Color fundus photograph; camera: Kowa VX-10α; macula-centered field — 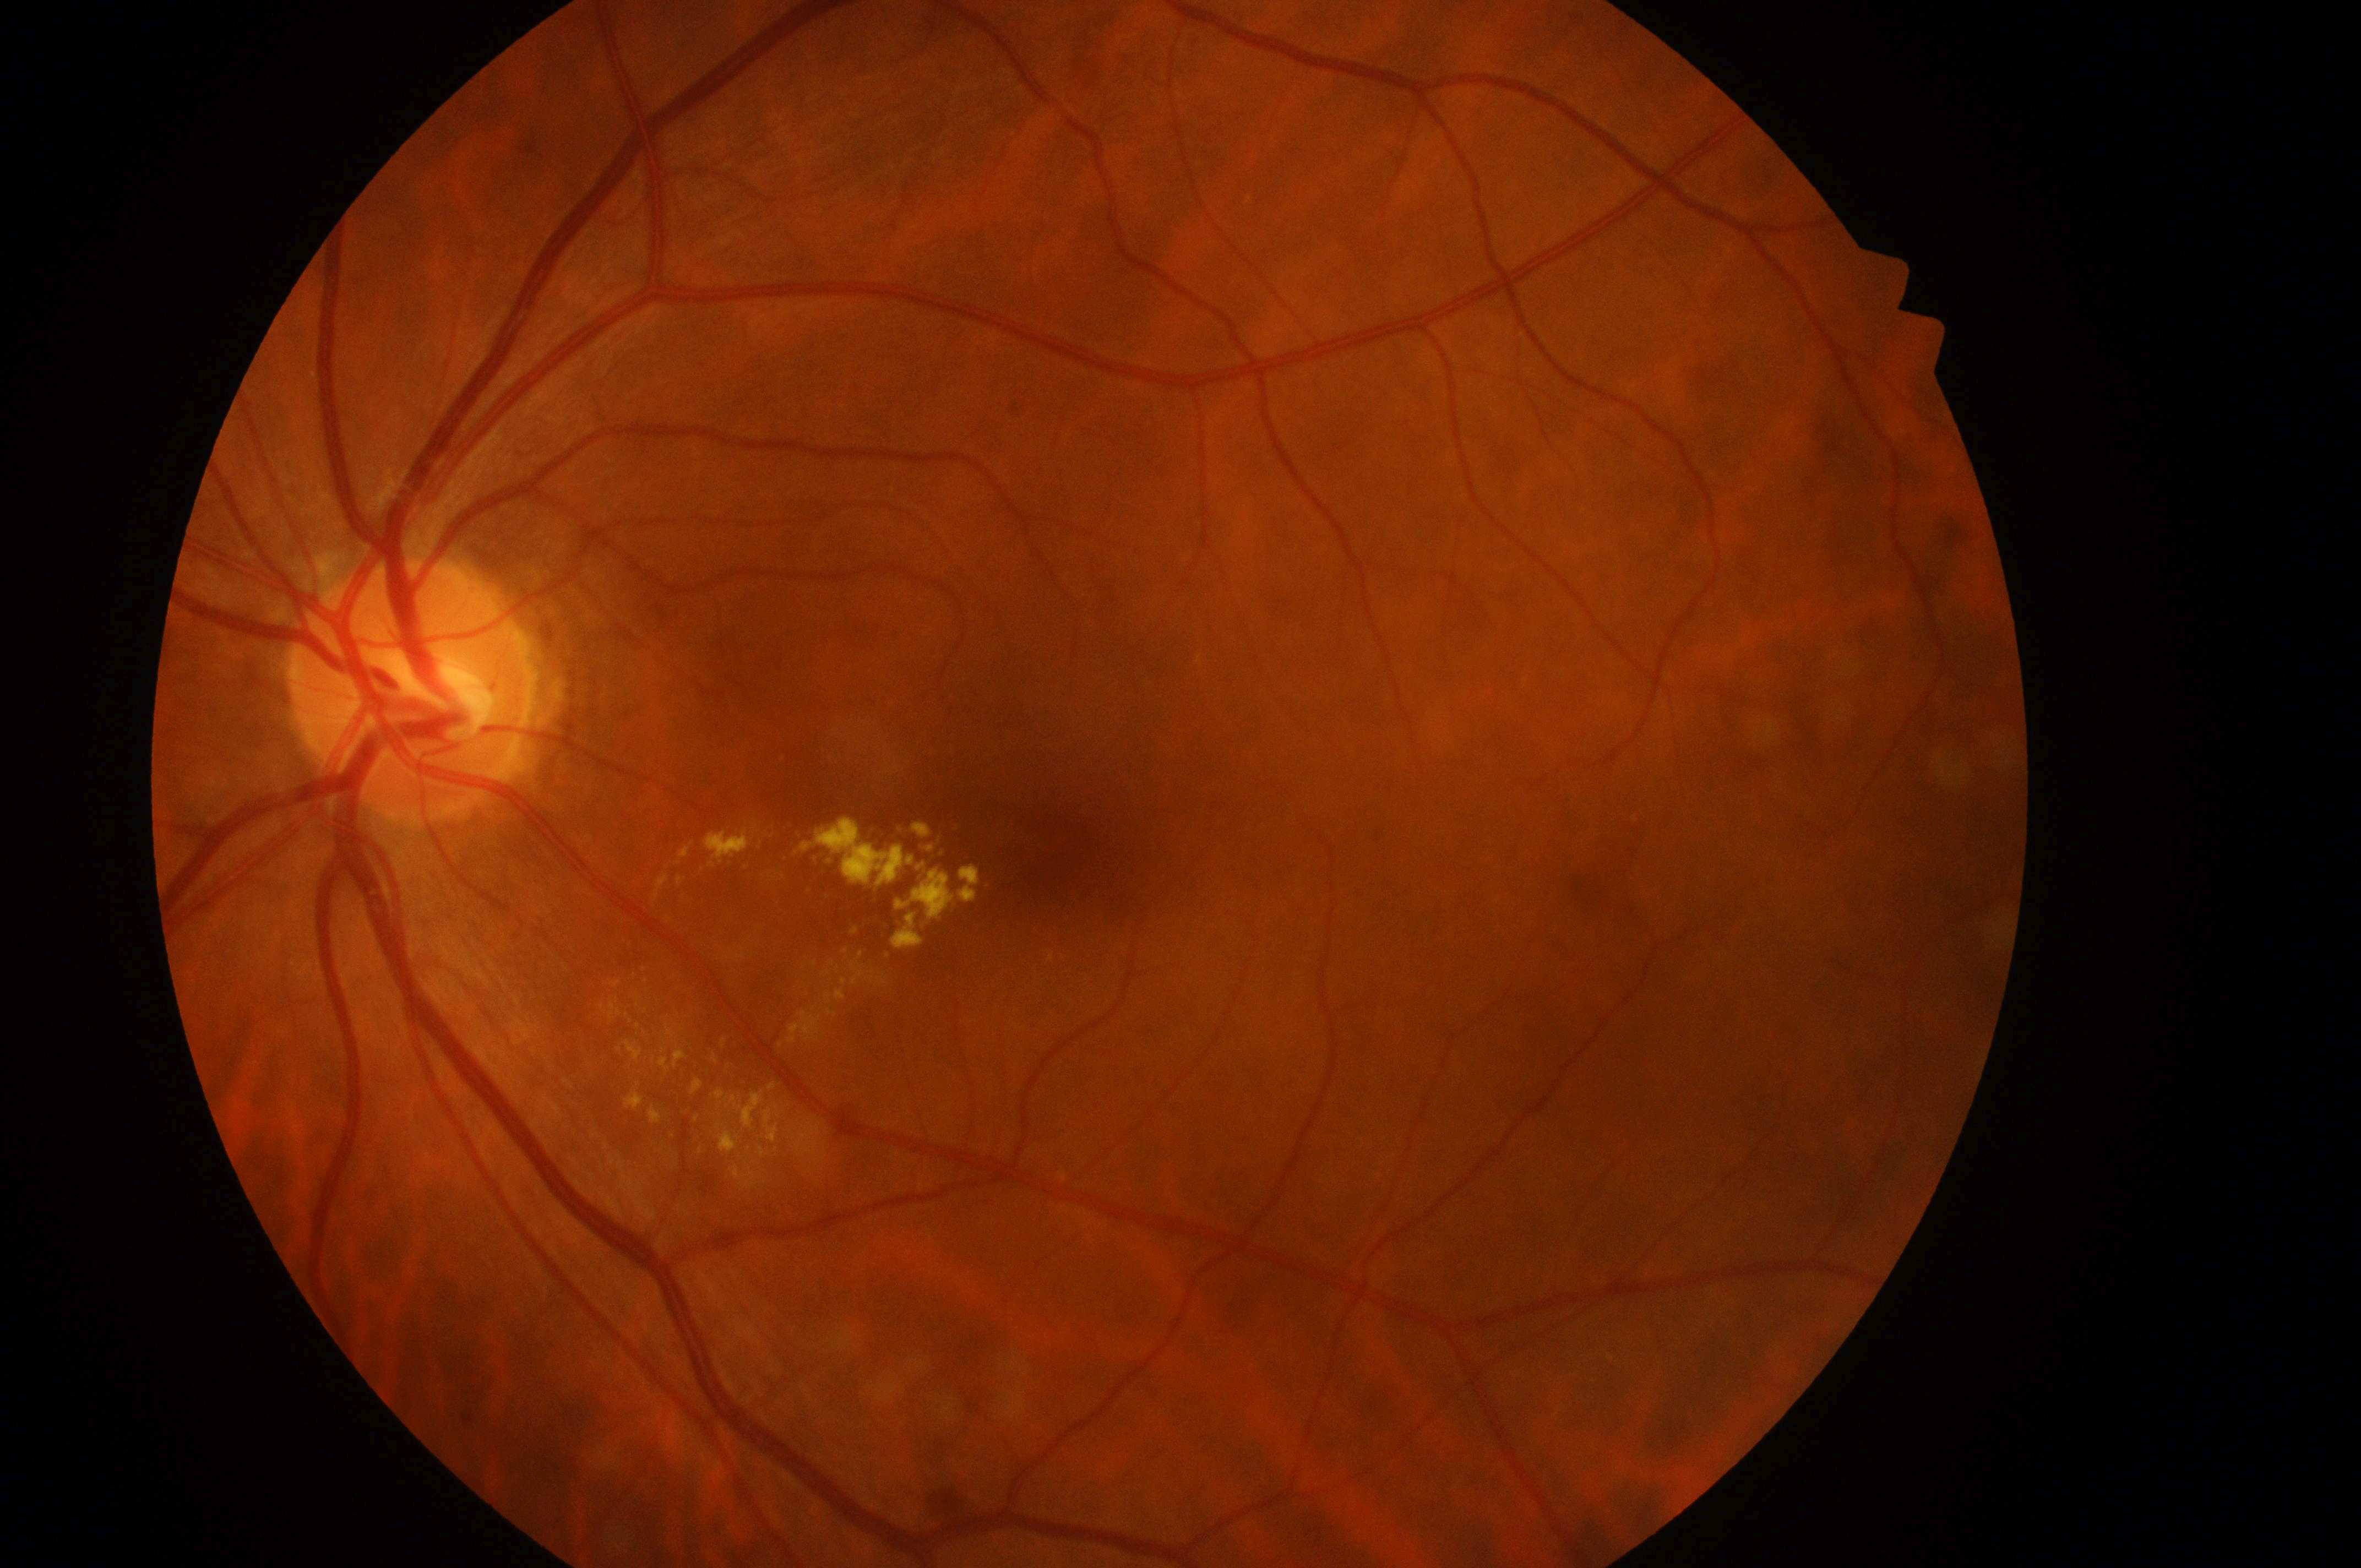
Fovea located at (x: 1068, y: 856).
Disc center: (x: 406, y: 694).
Diabetic retinopathy (DR): grade 2 (moderate NPDR).
Diabetic macular edema (DME): high risk (grade 2).
Imaged eye: the left eye.